Fundus photo, 45-degree field of view, 848x848, no pharmacologic dilation, camera: NIDEK AFC-230 — 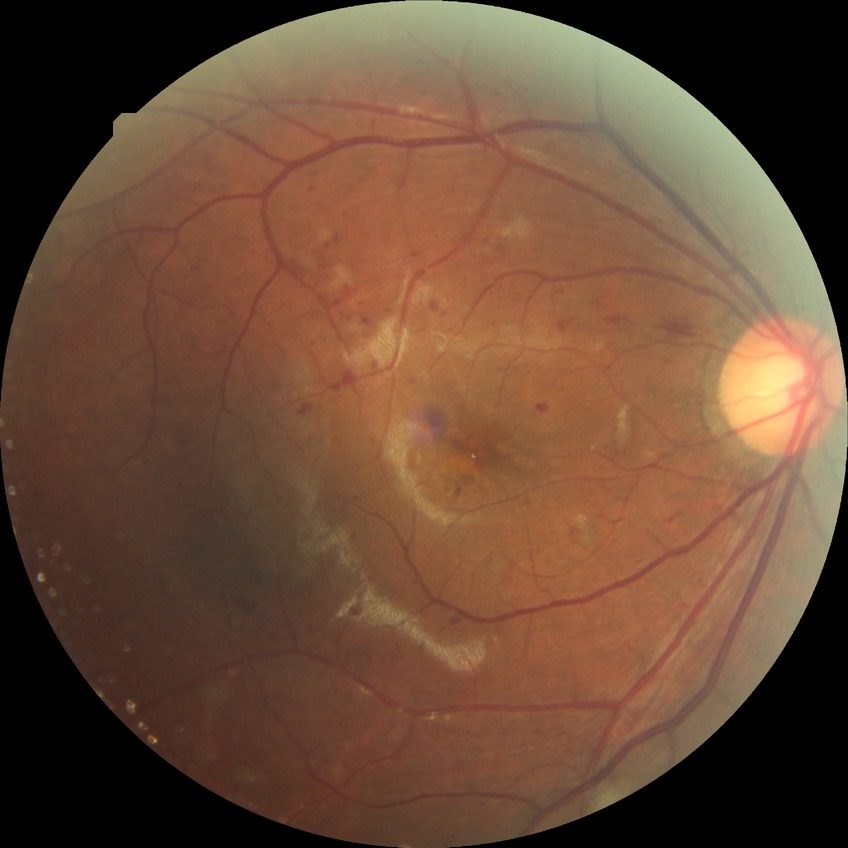
The retinopathy is classified as non-proliferative diabetic retinopathy.
Davis DR grade: PPDR.